Wide-field fundus photograph from neonatal ROP screening: 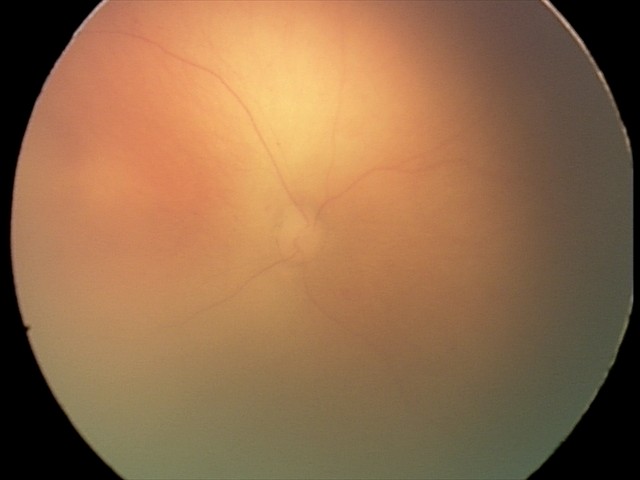

Examination diagnosed as retinopathy of prematurity (ROP) stage 0 — incomplete retinal vascularization without a demarcation line.